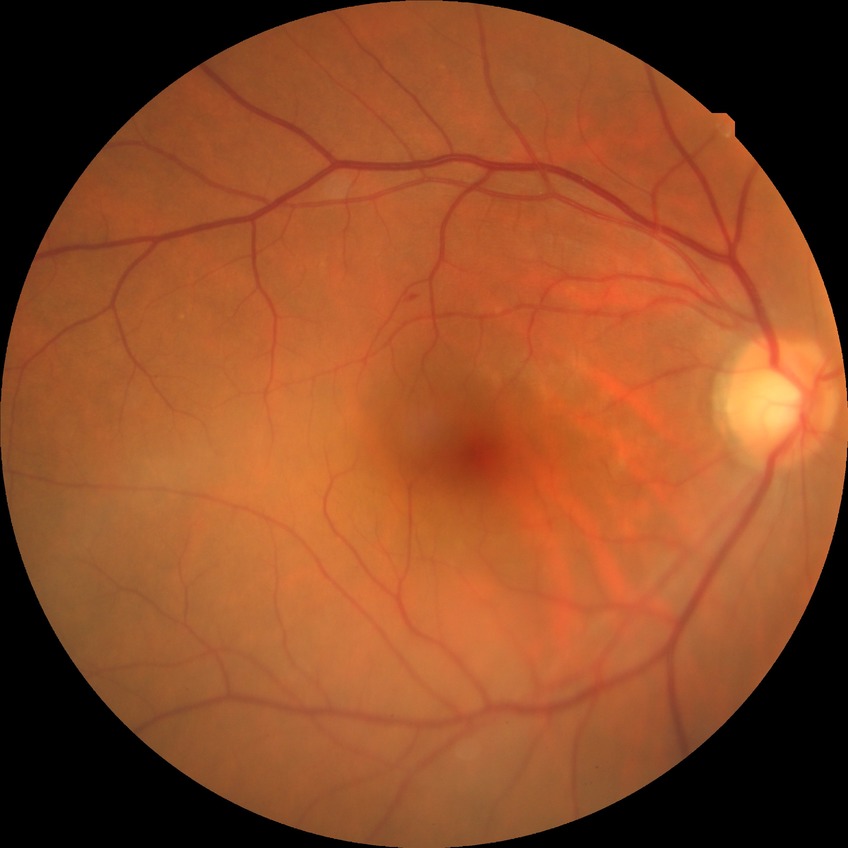

Diabetic retinopathy stage: no diabetic retinopathy.